2212x1659px. 60° field of view. Portable fundus photograph — 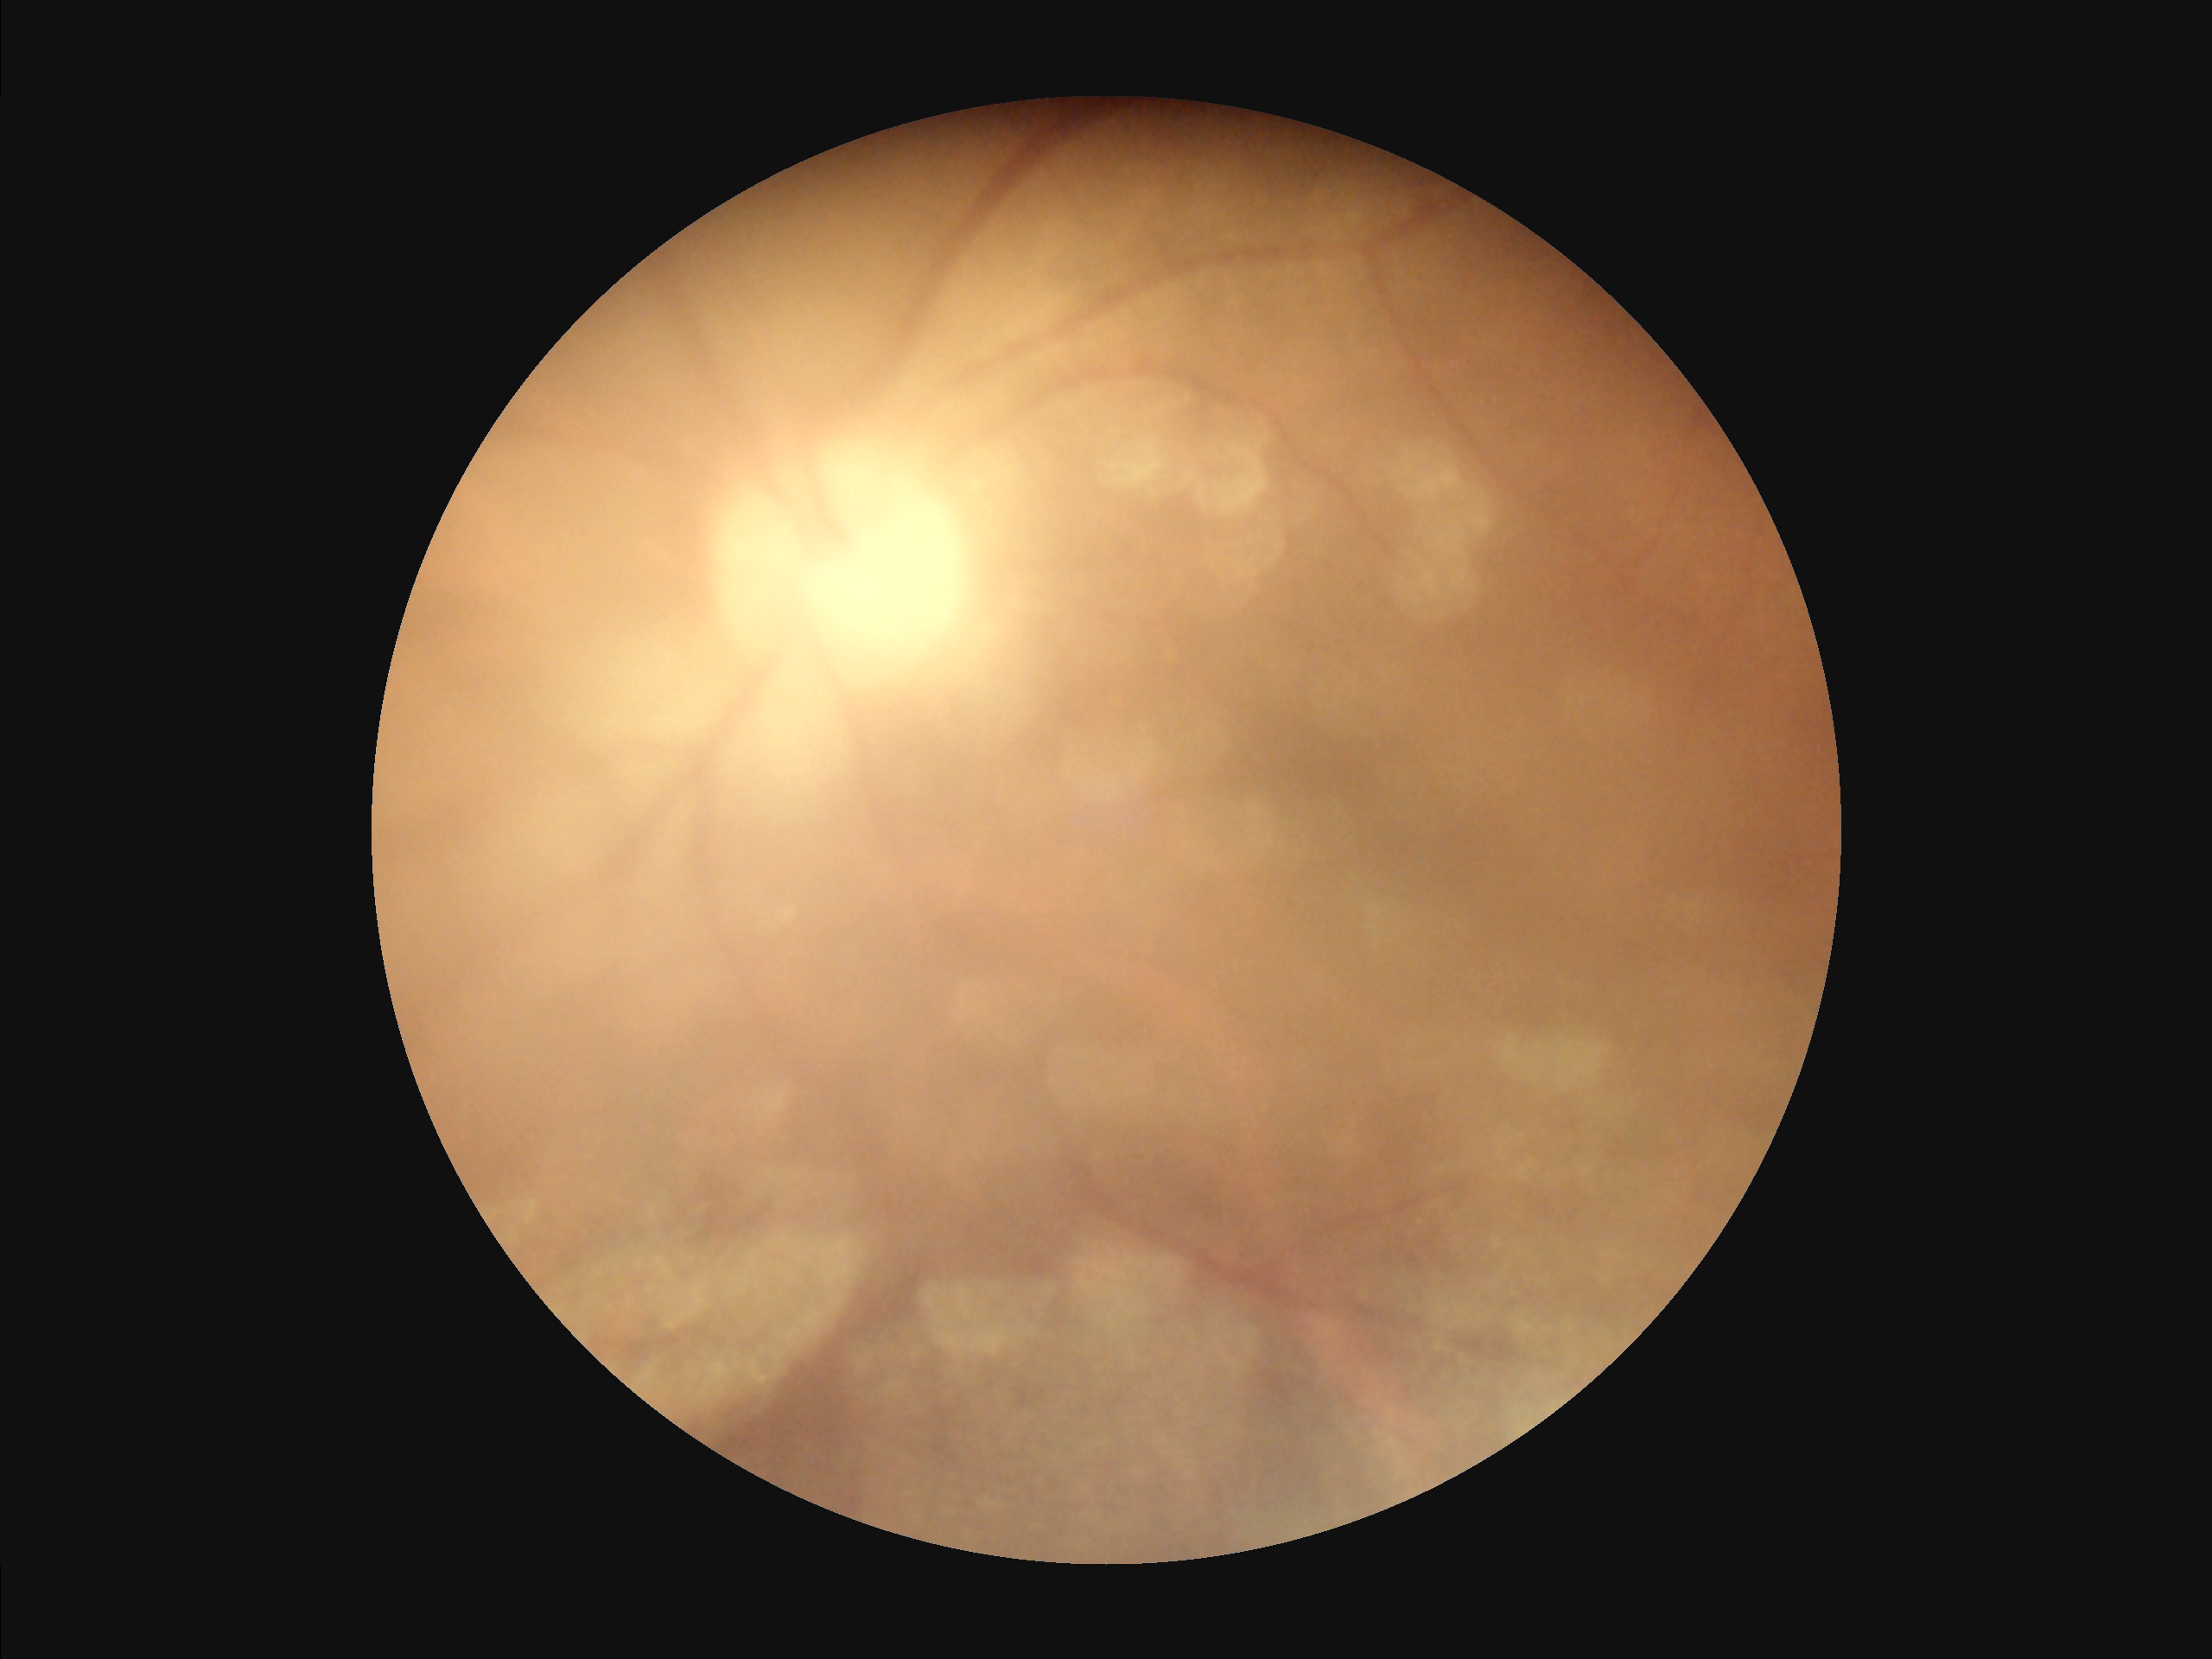
Poor dynamic range.
The image is blurry.
Image quality is inadequate for diagnostic use.
Even illumination with no color cast.